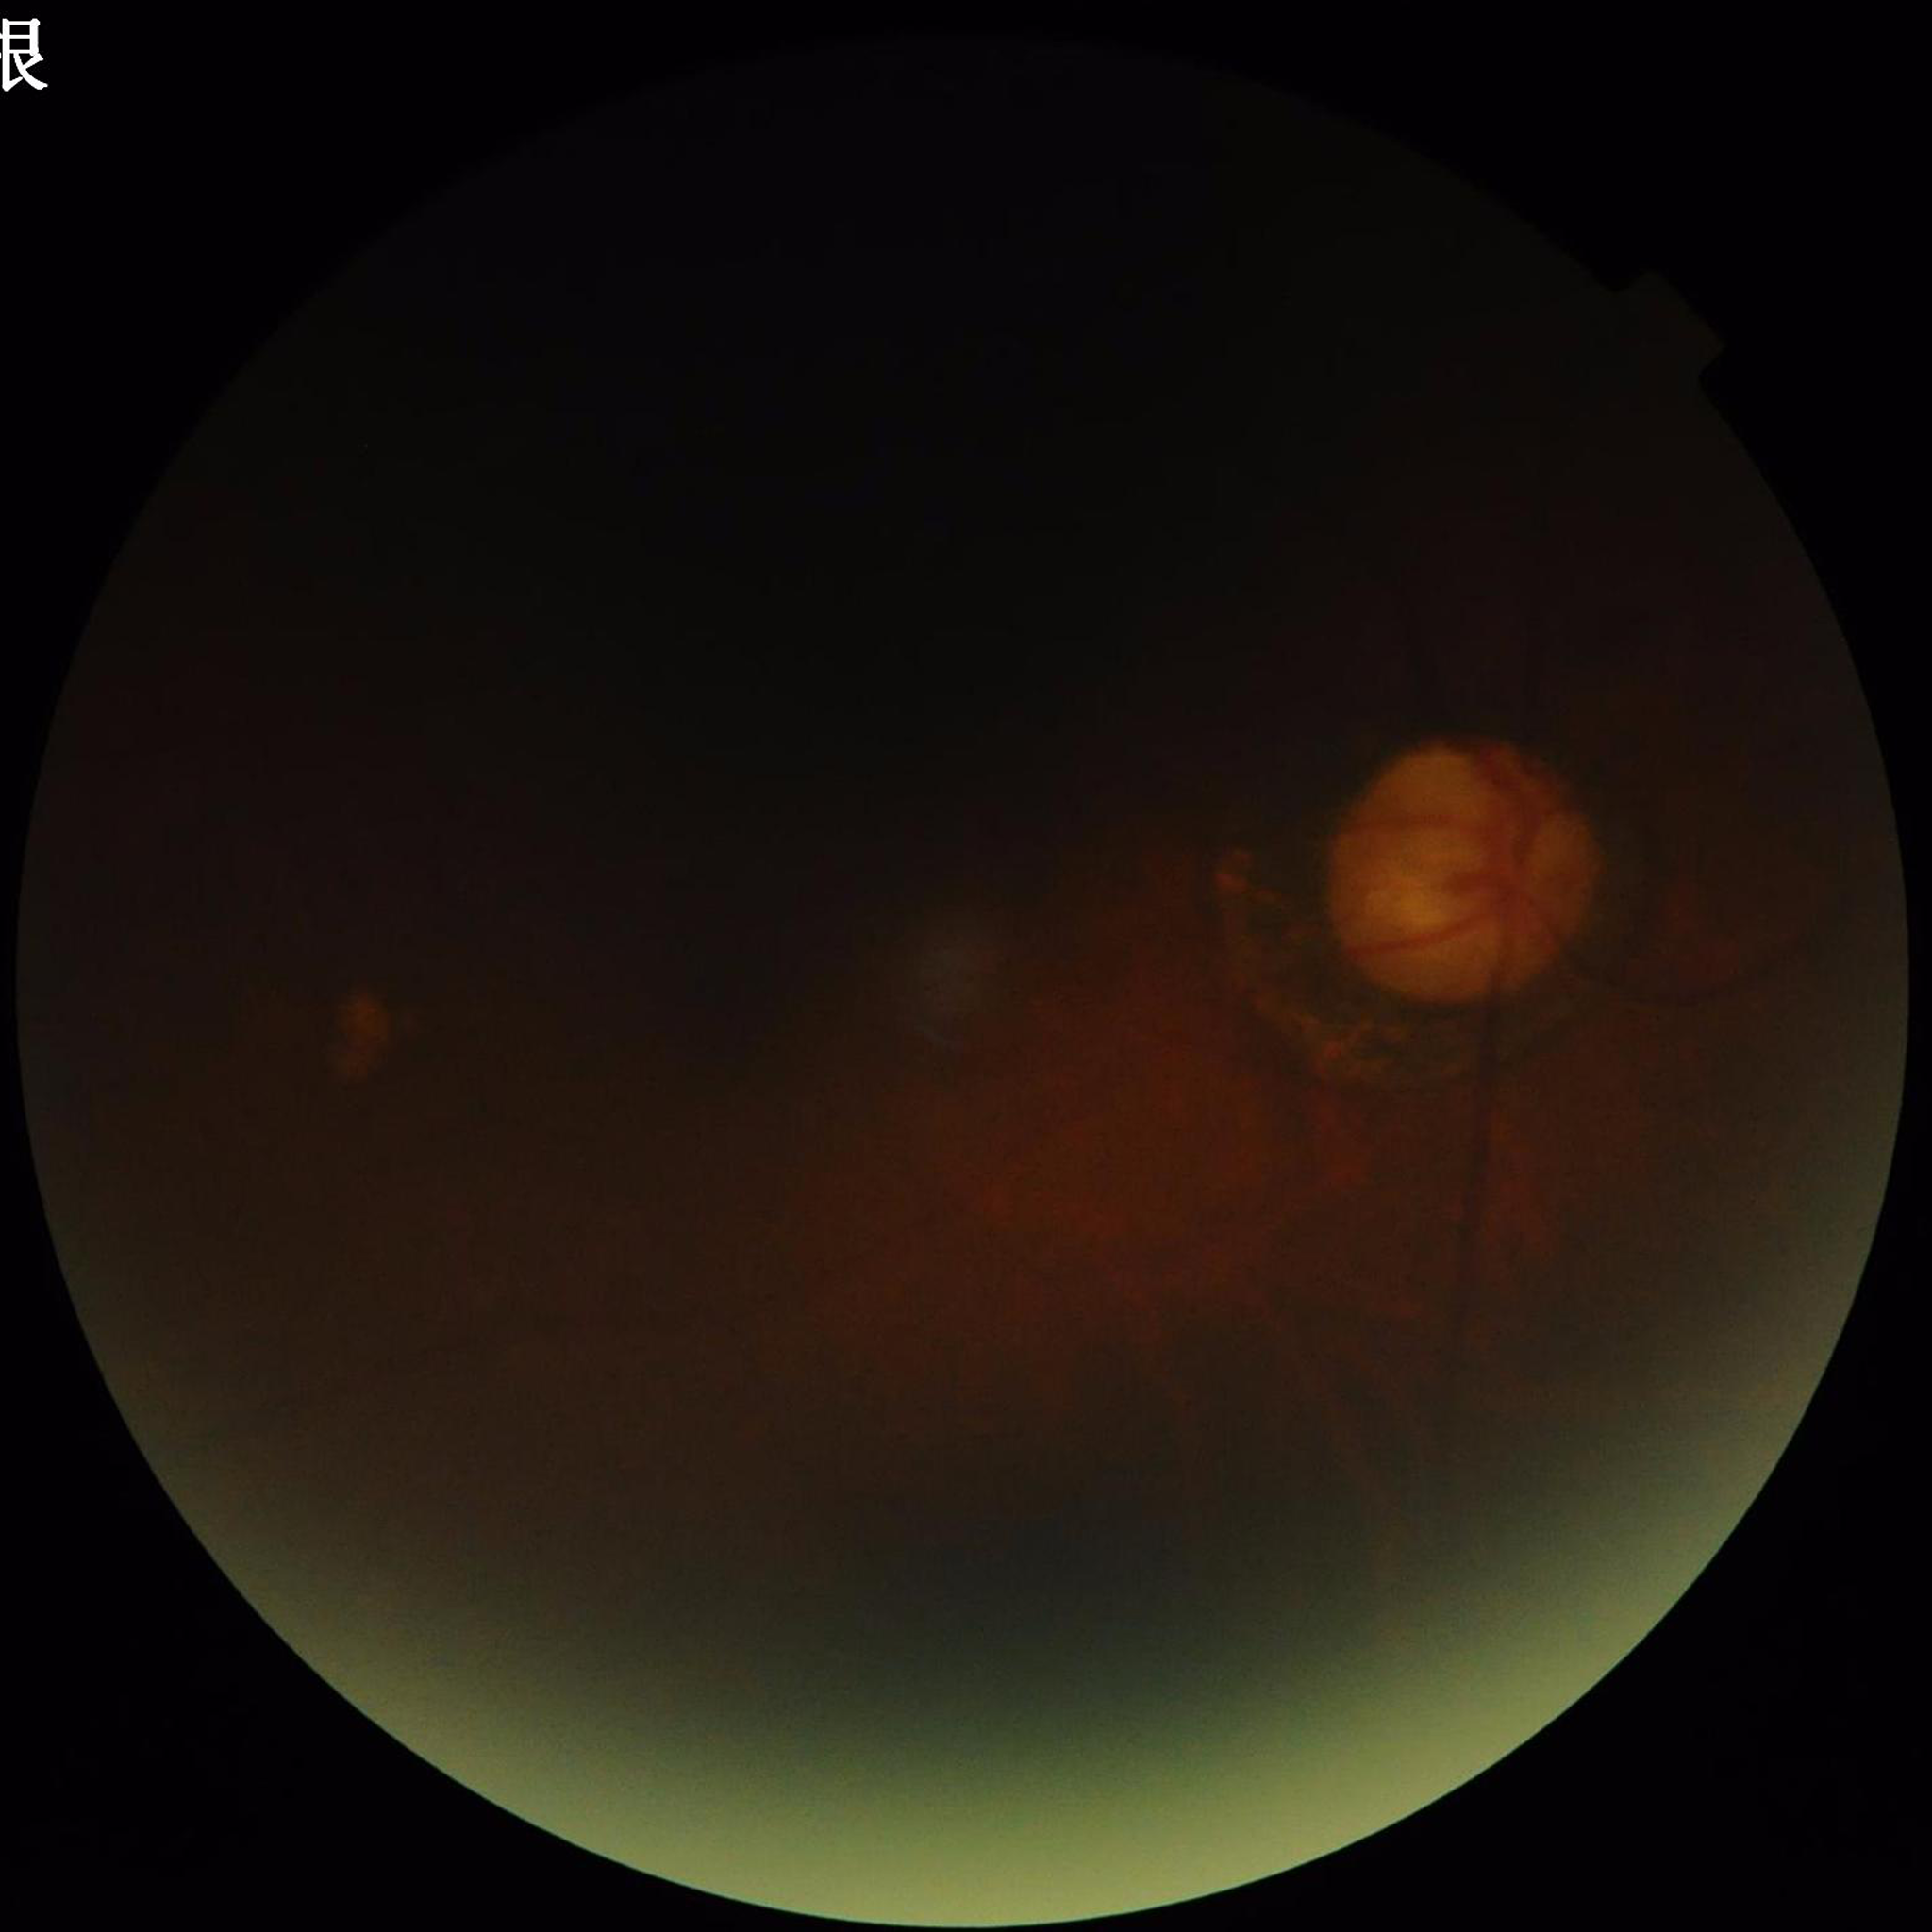

Disease class: glaucoma | Automated quality assessment: issues noted — blur, low contrast, illumination/color distortion.